Wide-field retinal mosaic image. 1924x1556px. FOV: 200 degrees
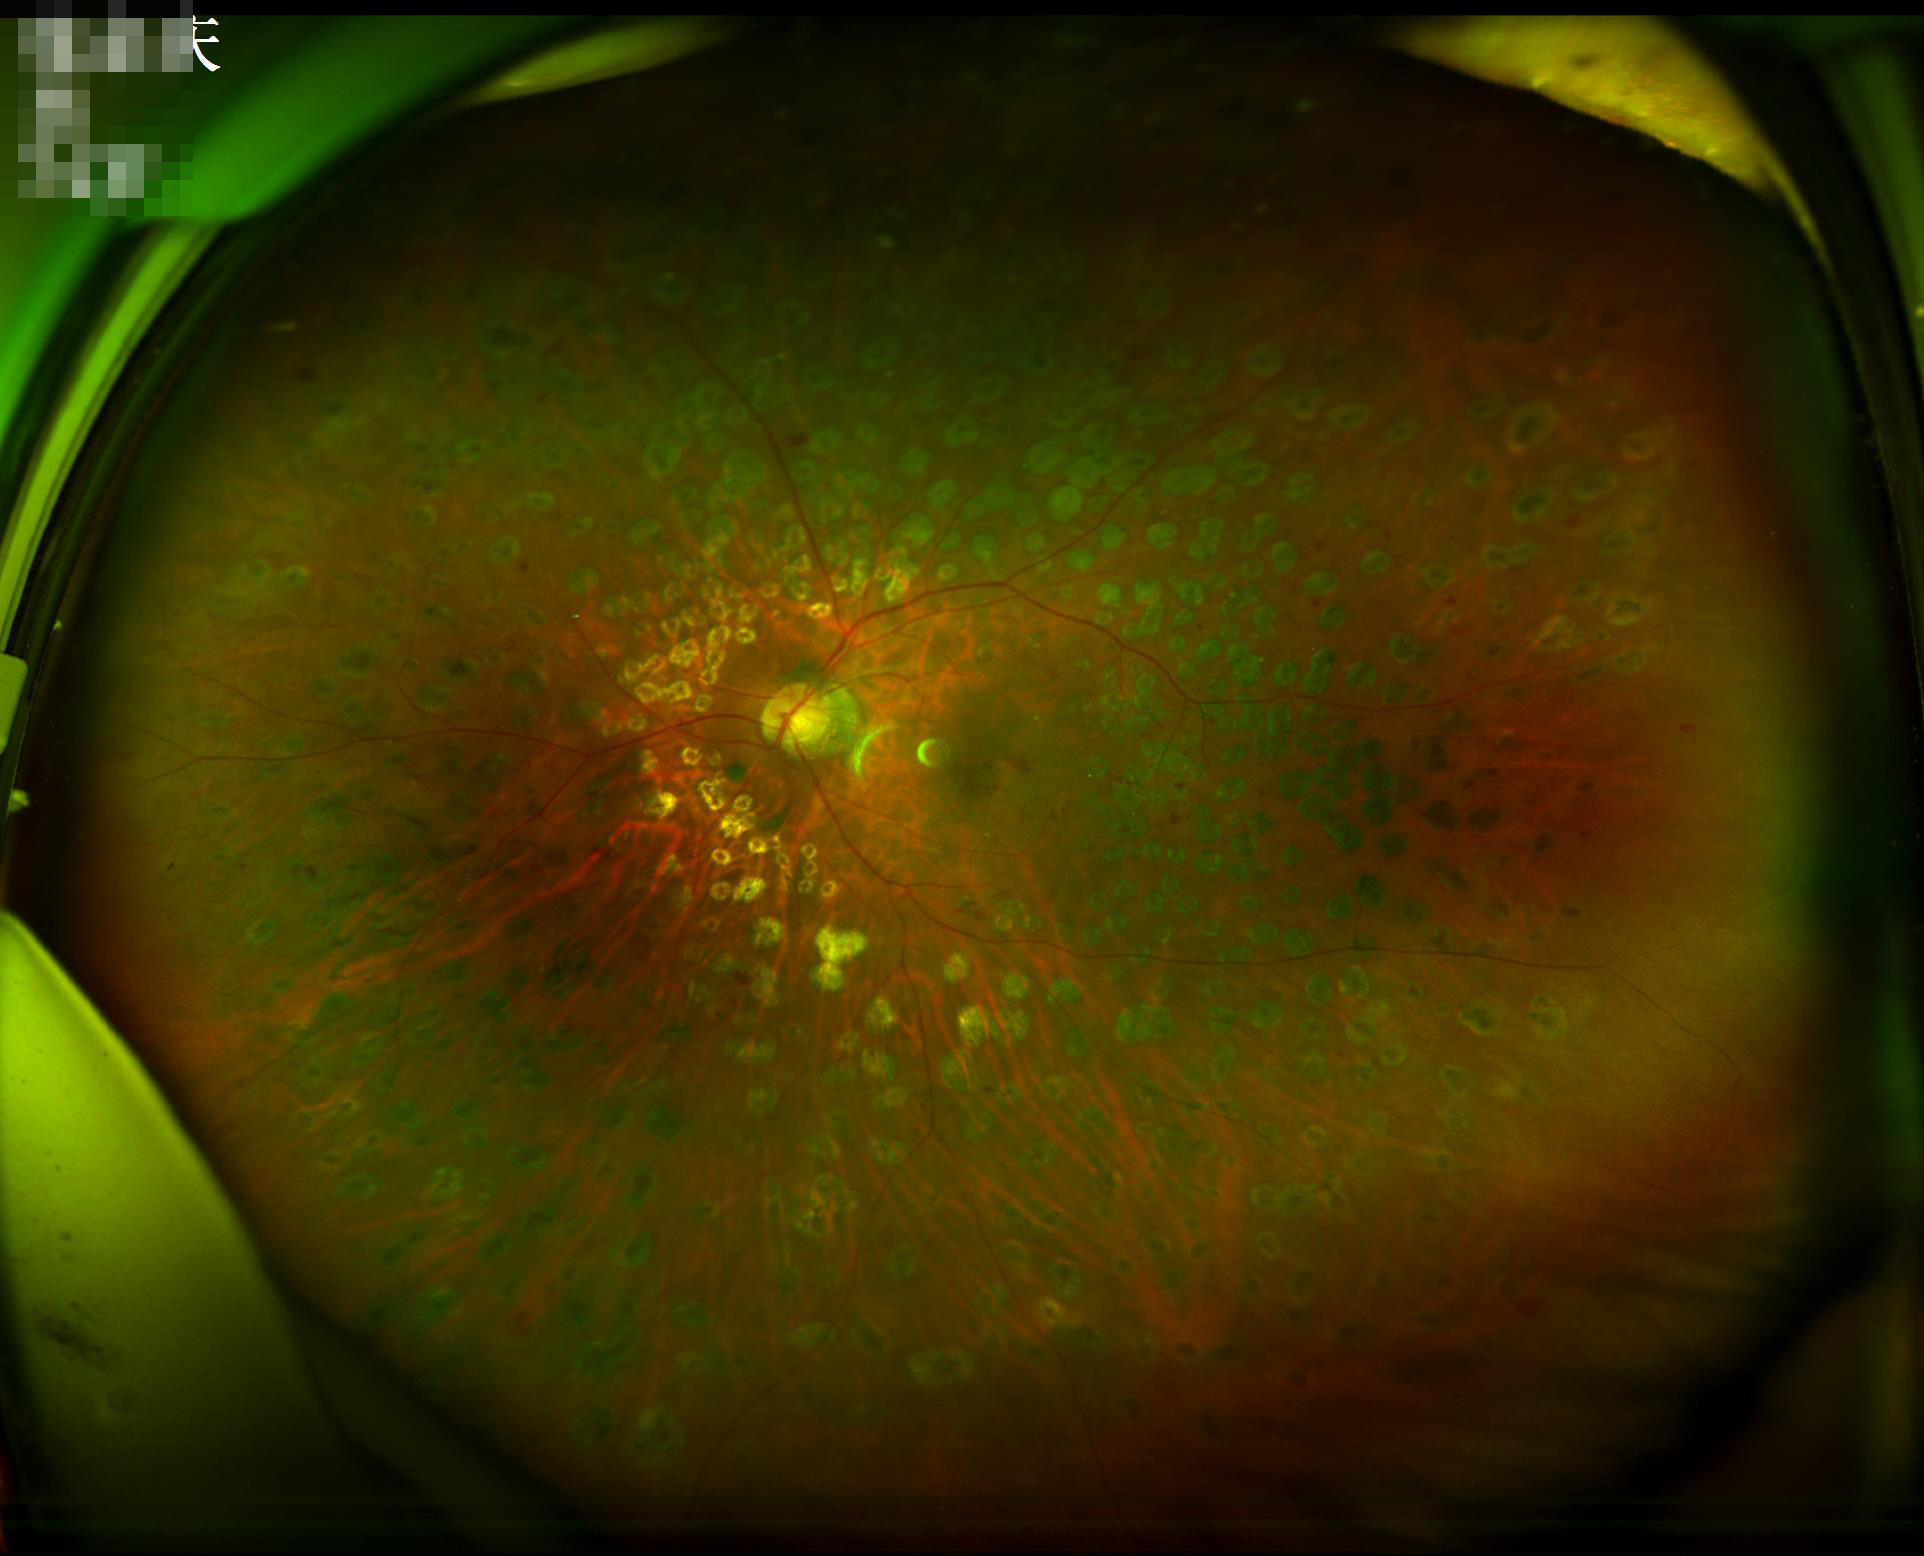 Overall image quality is good.
Illumination is uneven.
Adequate contrast for distinguishing structures.